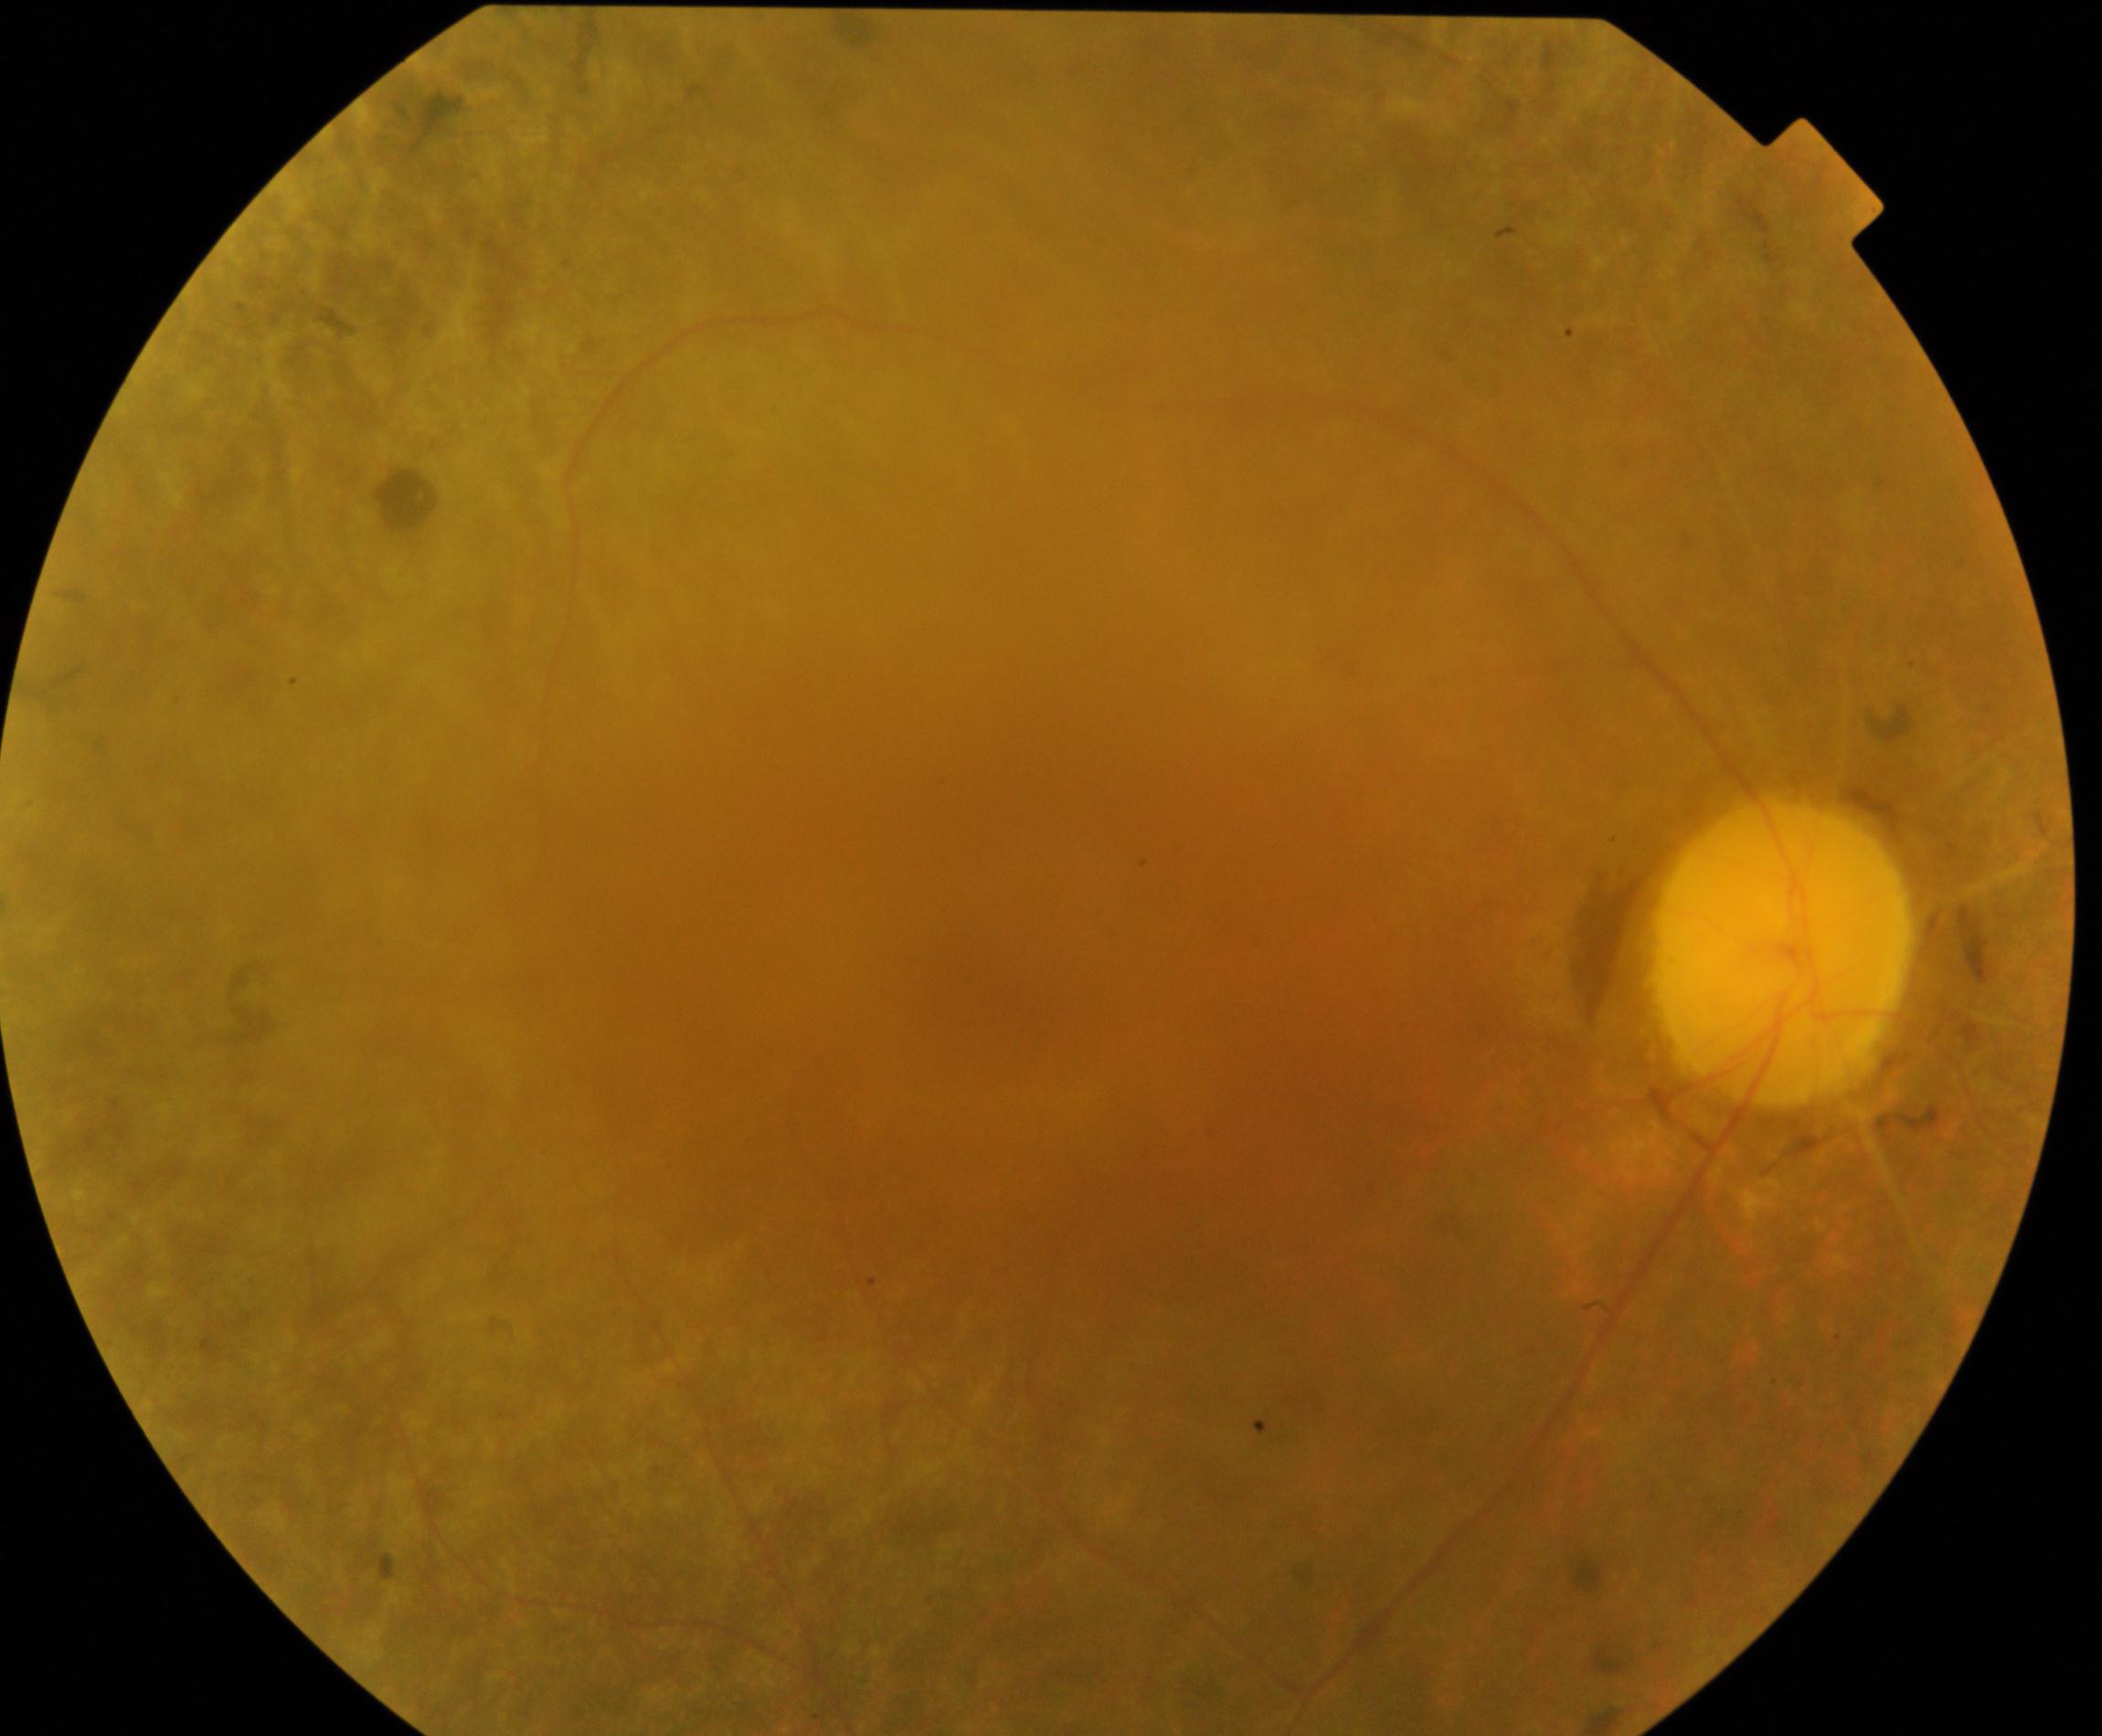

Classification: retinitis pigmentosa.